Retinal fundus photograph
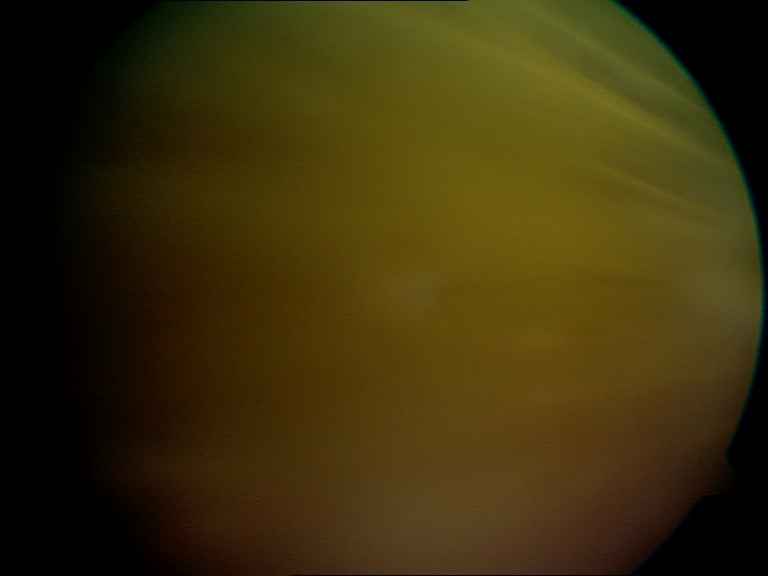 Image is blurred; retinal landmarks are largely obscured. Proliferative diabetic retinopathy not identified in the visible portion.